Nonmydriatic. 45 degree fundus photograph. Acquired with a NIDEK AFC-230. 848 by 848 pixels — 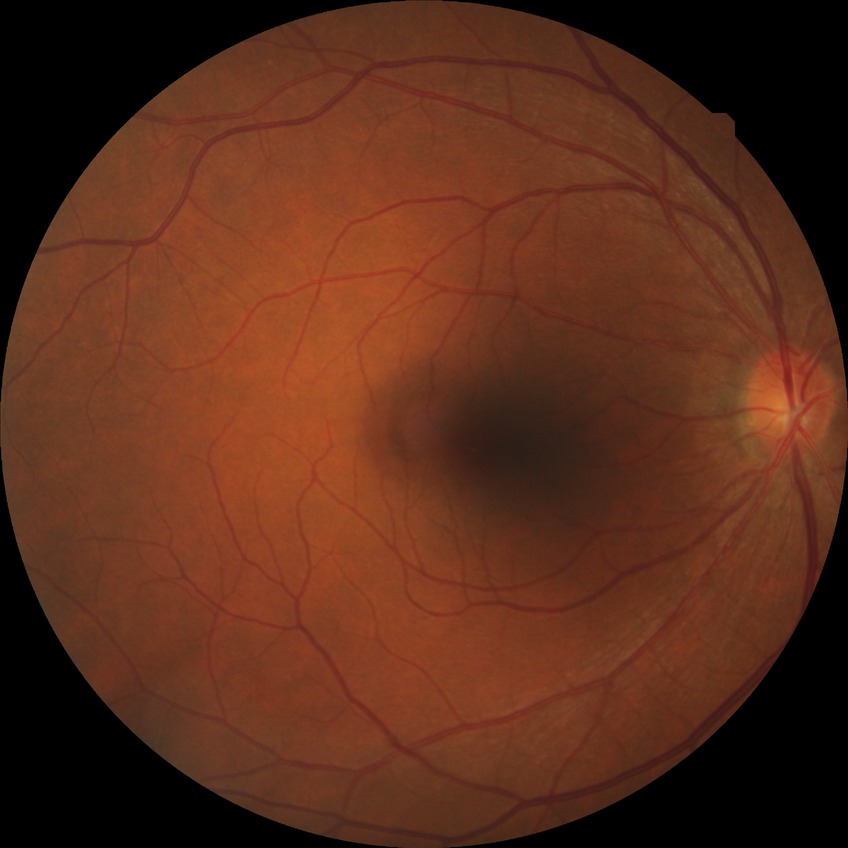

Annotations:
- diabetic retinopathy severity — no diabetic retinopathy